45° field of view · NIDEK AFC-230 · 848x848 · without pupil dilation: 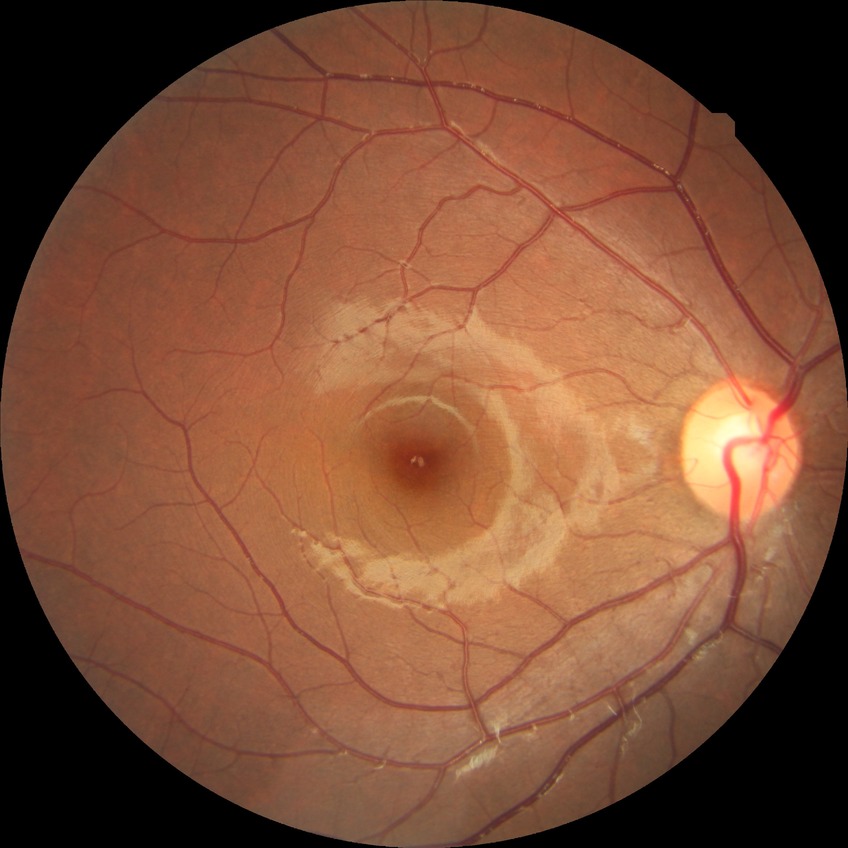 Modified Davis grade: NDR.
No signs of diabetic retinopathy.